Infant wide-field retinal image; image size 1240x1240 — 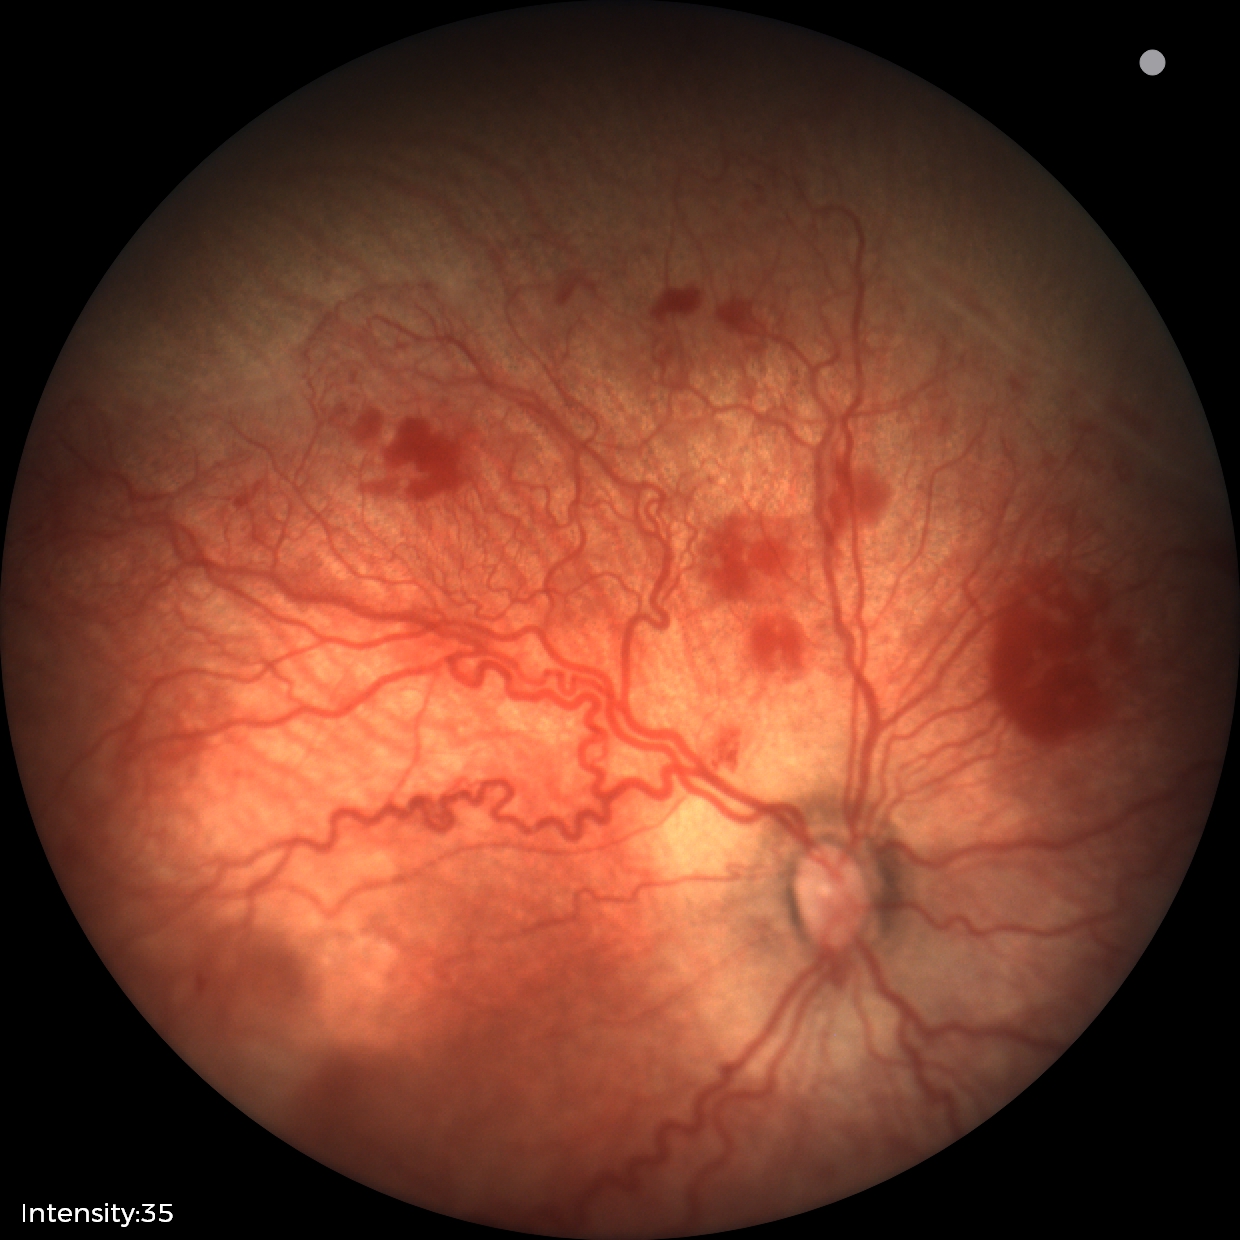 Assessment: plus disease; retinopathy of prematurity stage 2.